Wide-field fundus photograph of an infant; 640 by 480 pixels: 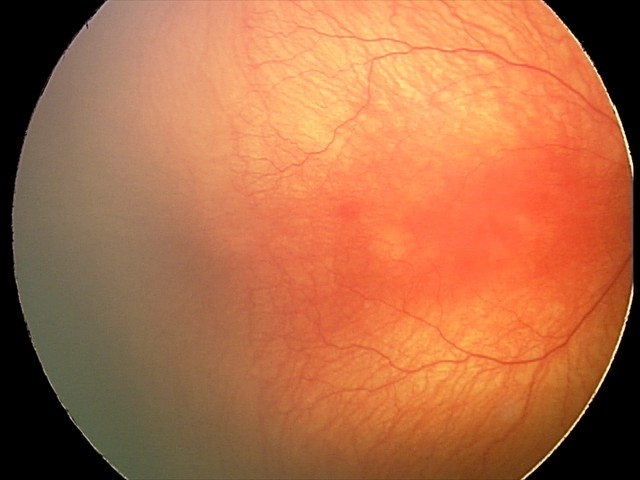 Diagnosis from this screening exam: aggressive retinopathy of prematurity. With plus disease.